Pediatric wide-field fundus photograph.
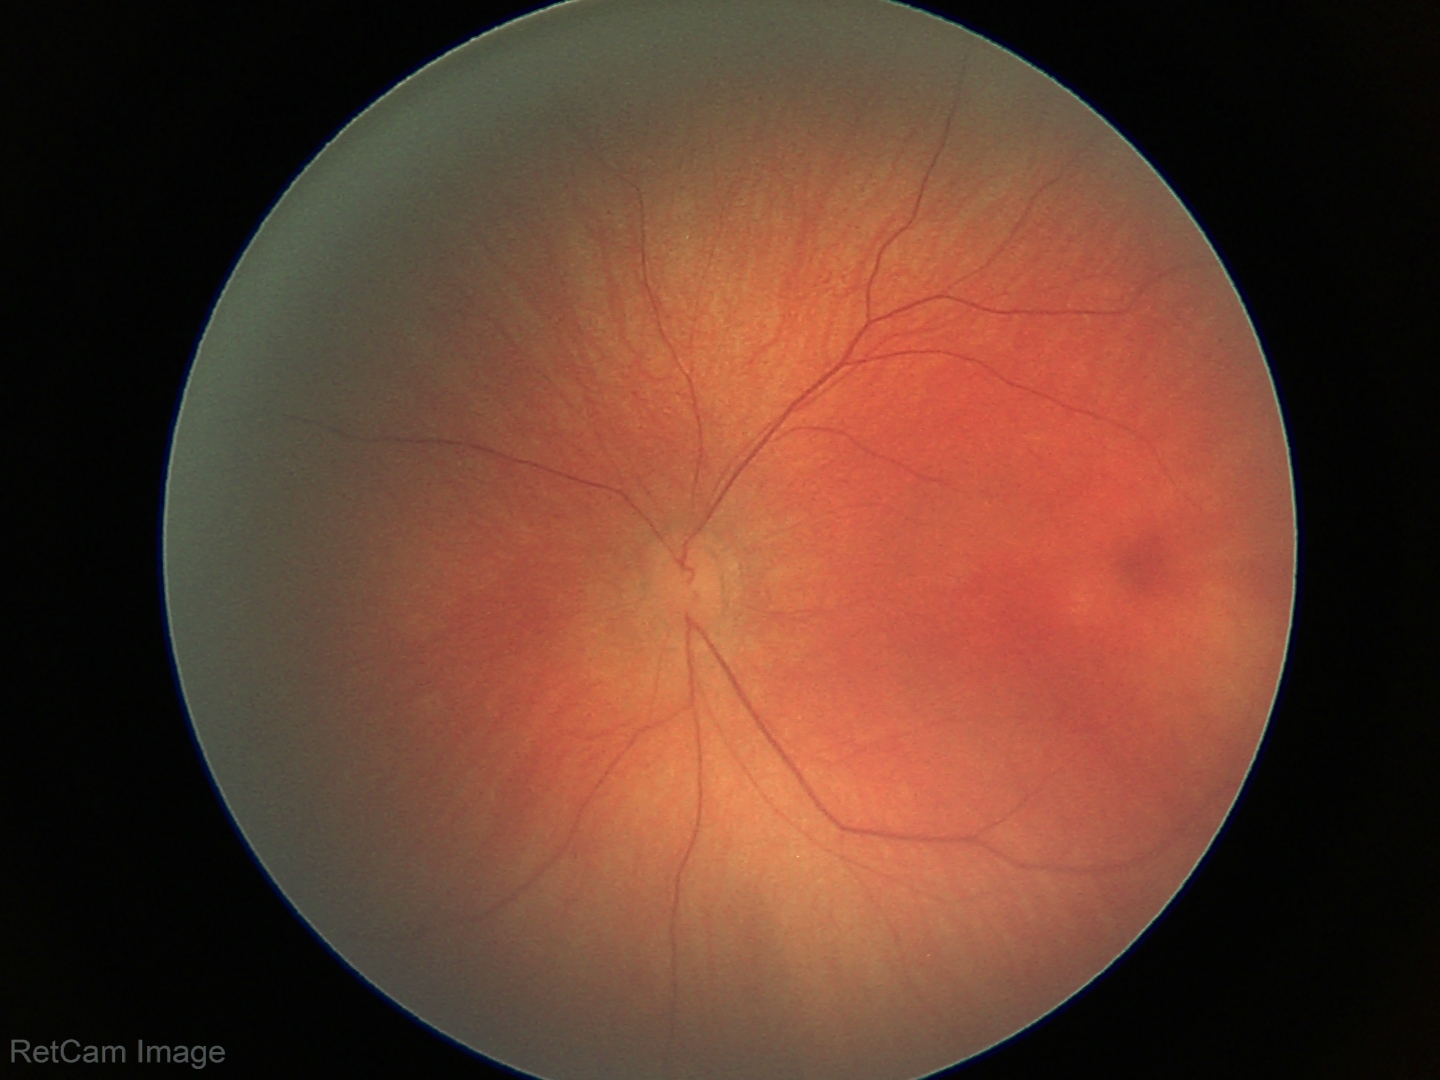
Impression: normal retinal appearance.